2212 by 1659 pixels; retinal fundus photograph; 45-degree field of view — 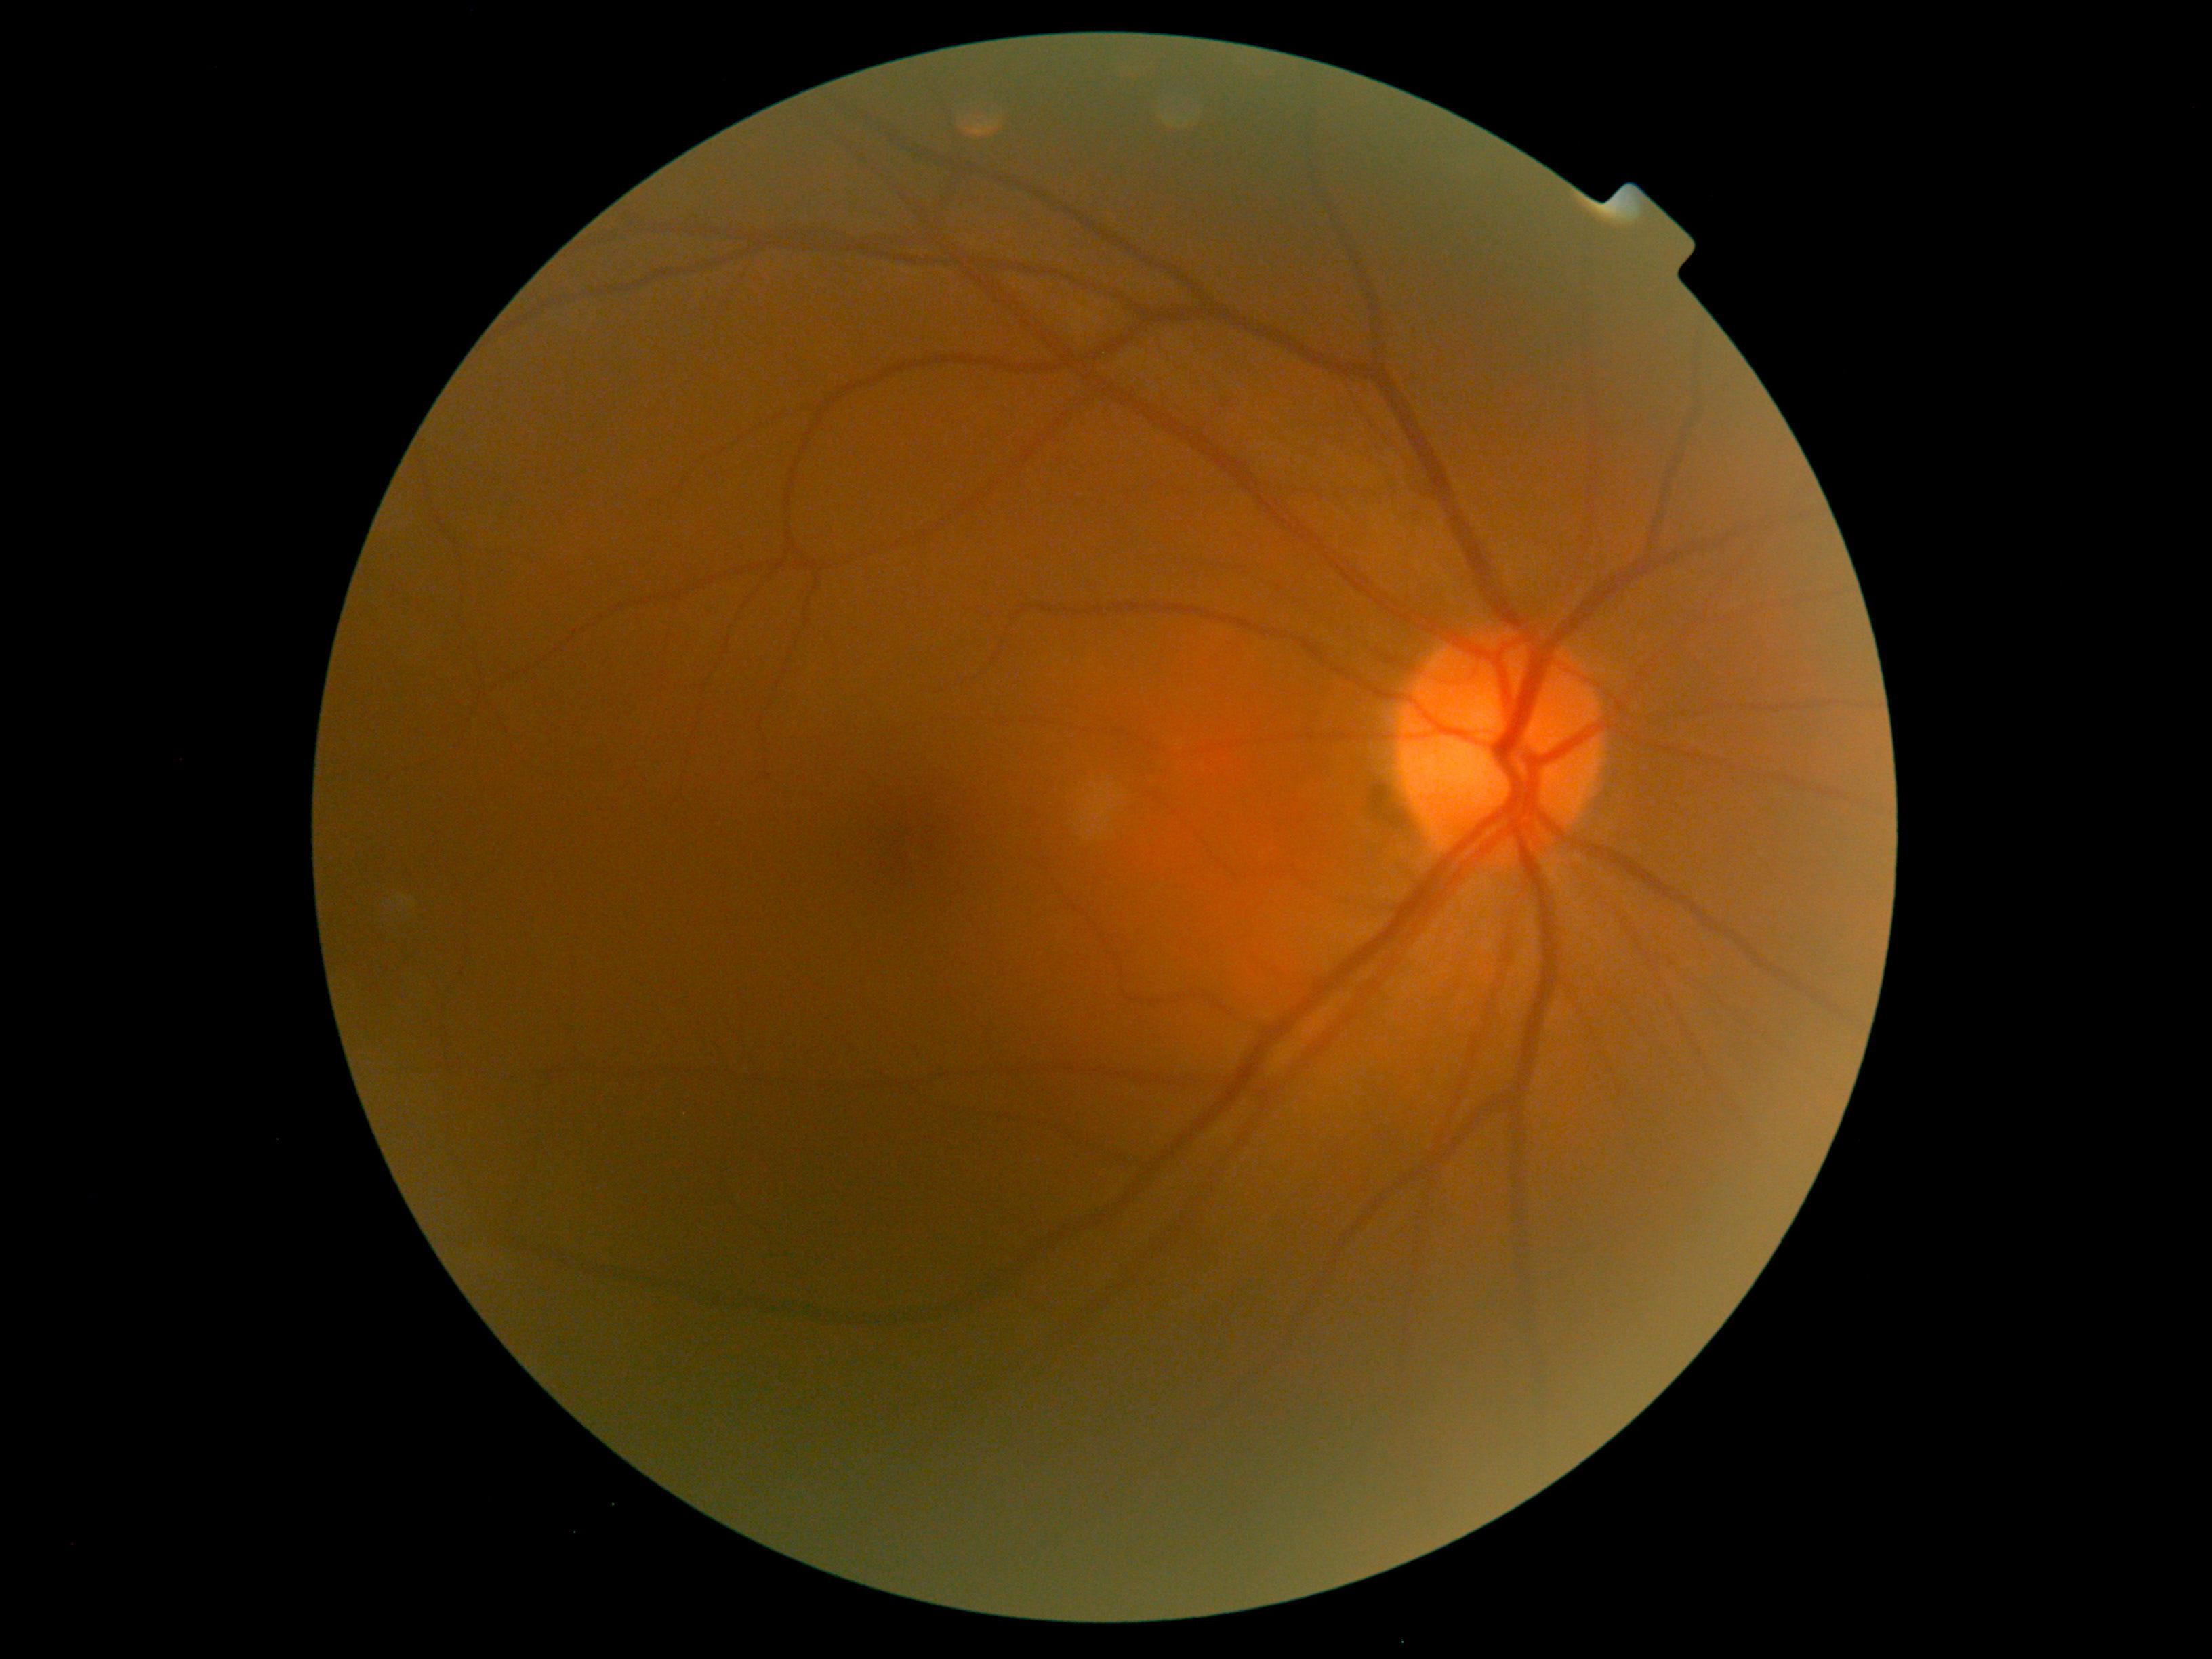 DR is no apparent retinopathy (grade 0). No DR findings.